45-degree field of view. Image size 2352x1568
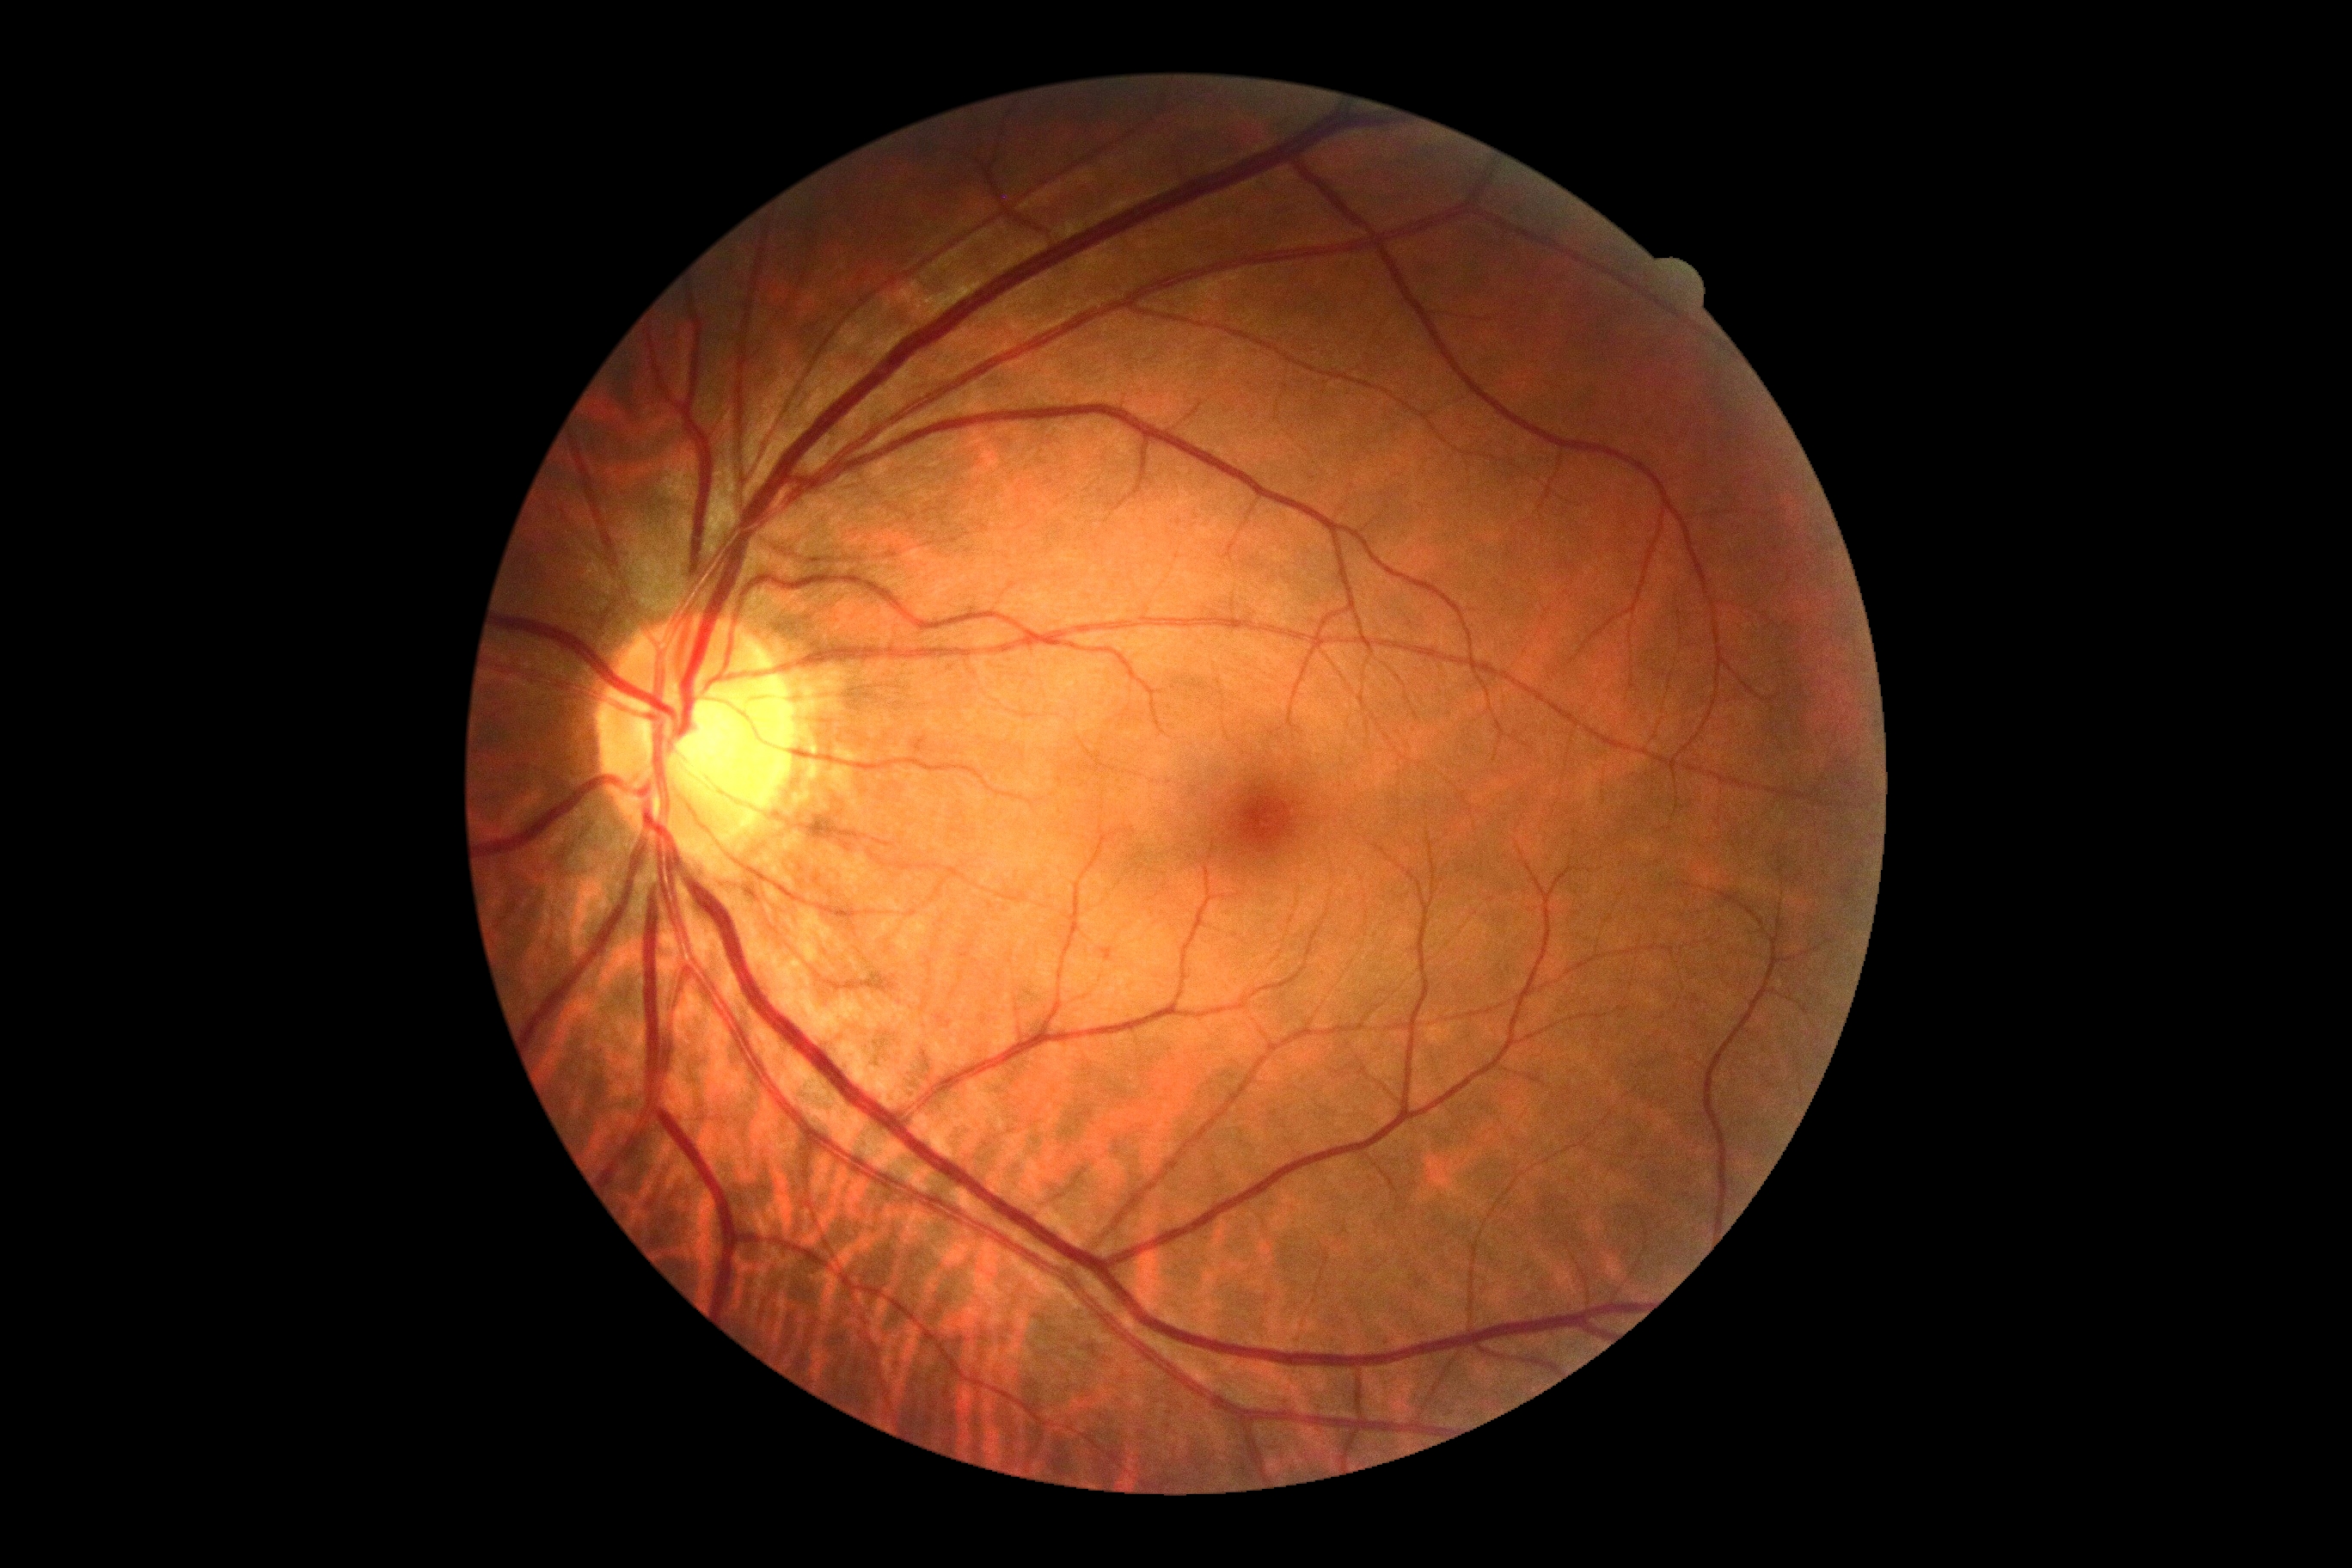 Diabetic retinopathy: grade 0 (no apparent retinopathy).